Nonmydriatic fundus photograph: 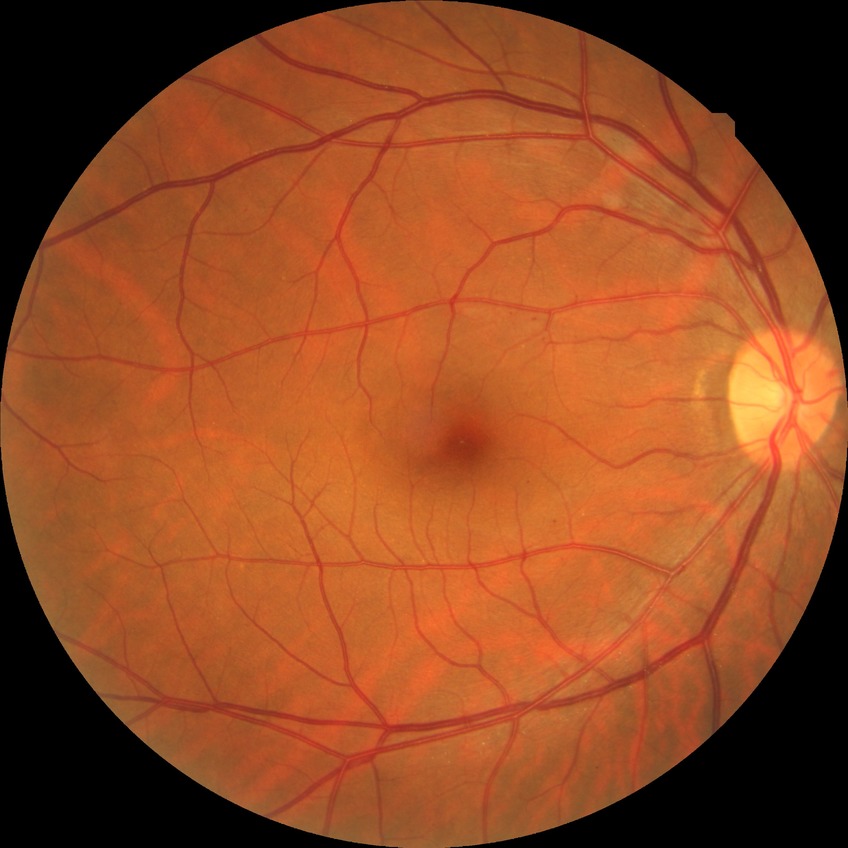 Diabetic retinopathy (DR) is simple diabetic retinopathy (SDR).